848 x 848 pixels. No pharmacologic dilation
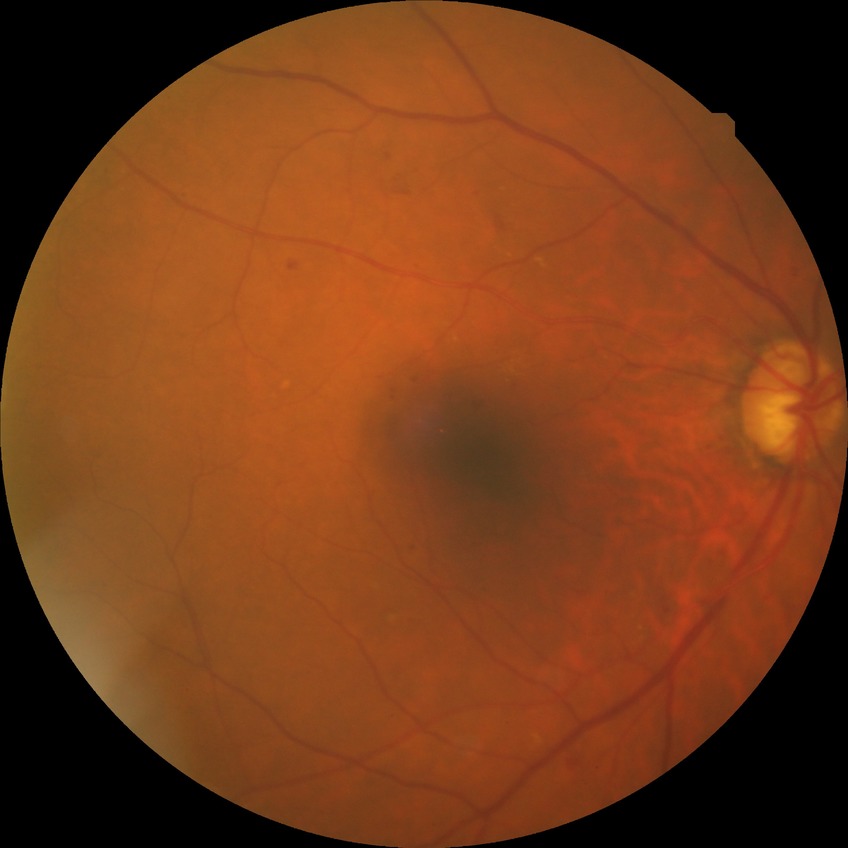

* retinopathy stage — simple diabetic retinopathy
* DR class — non-proliferative diabetic retinopathy